Modified Davis grading · FOV: 45 degrees · 848x848px: 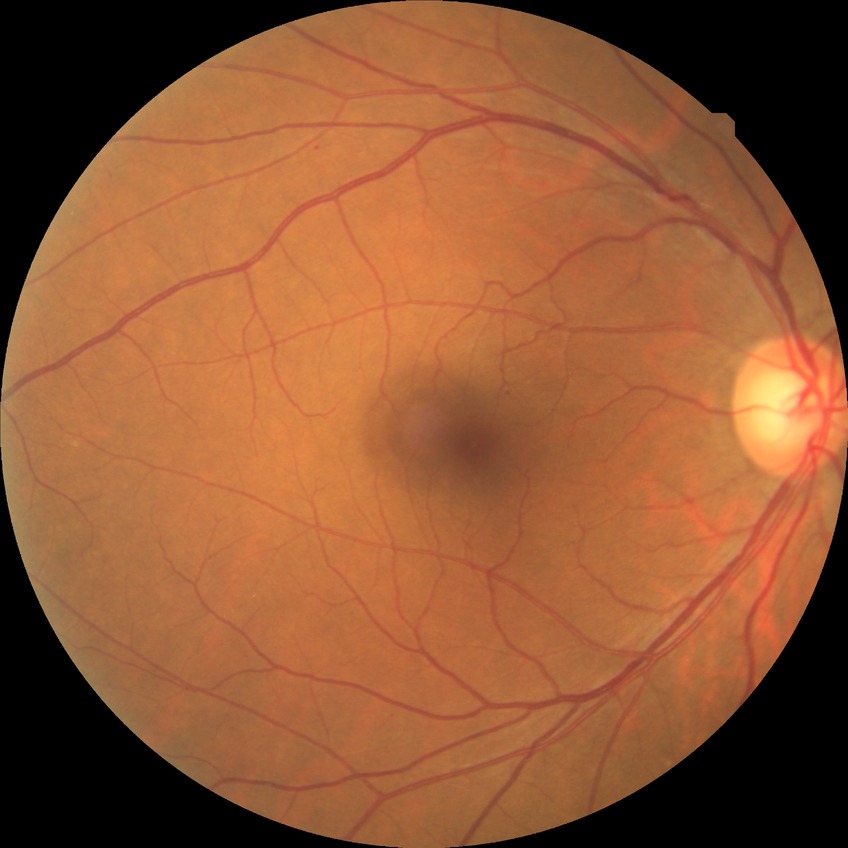 Davis DR grade = SDR.